2212x1659px, 45° field of view: 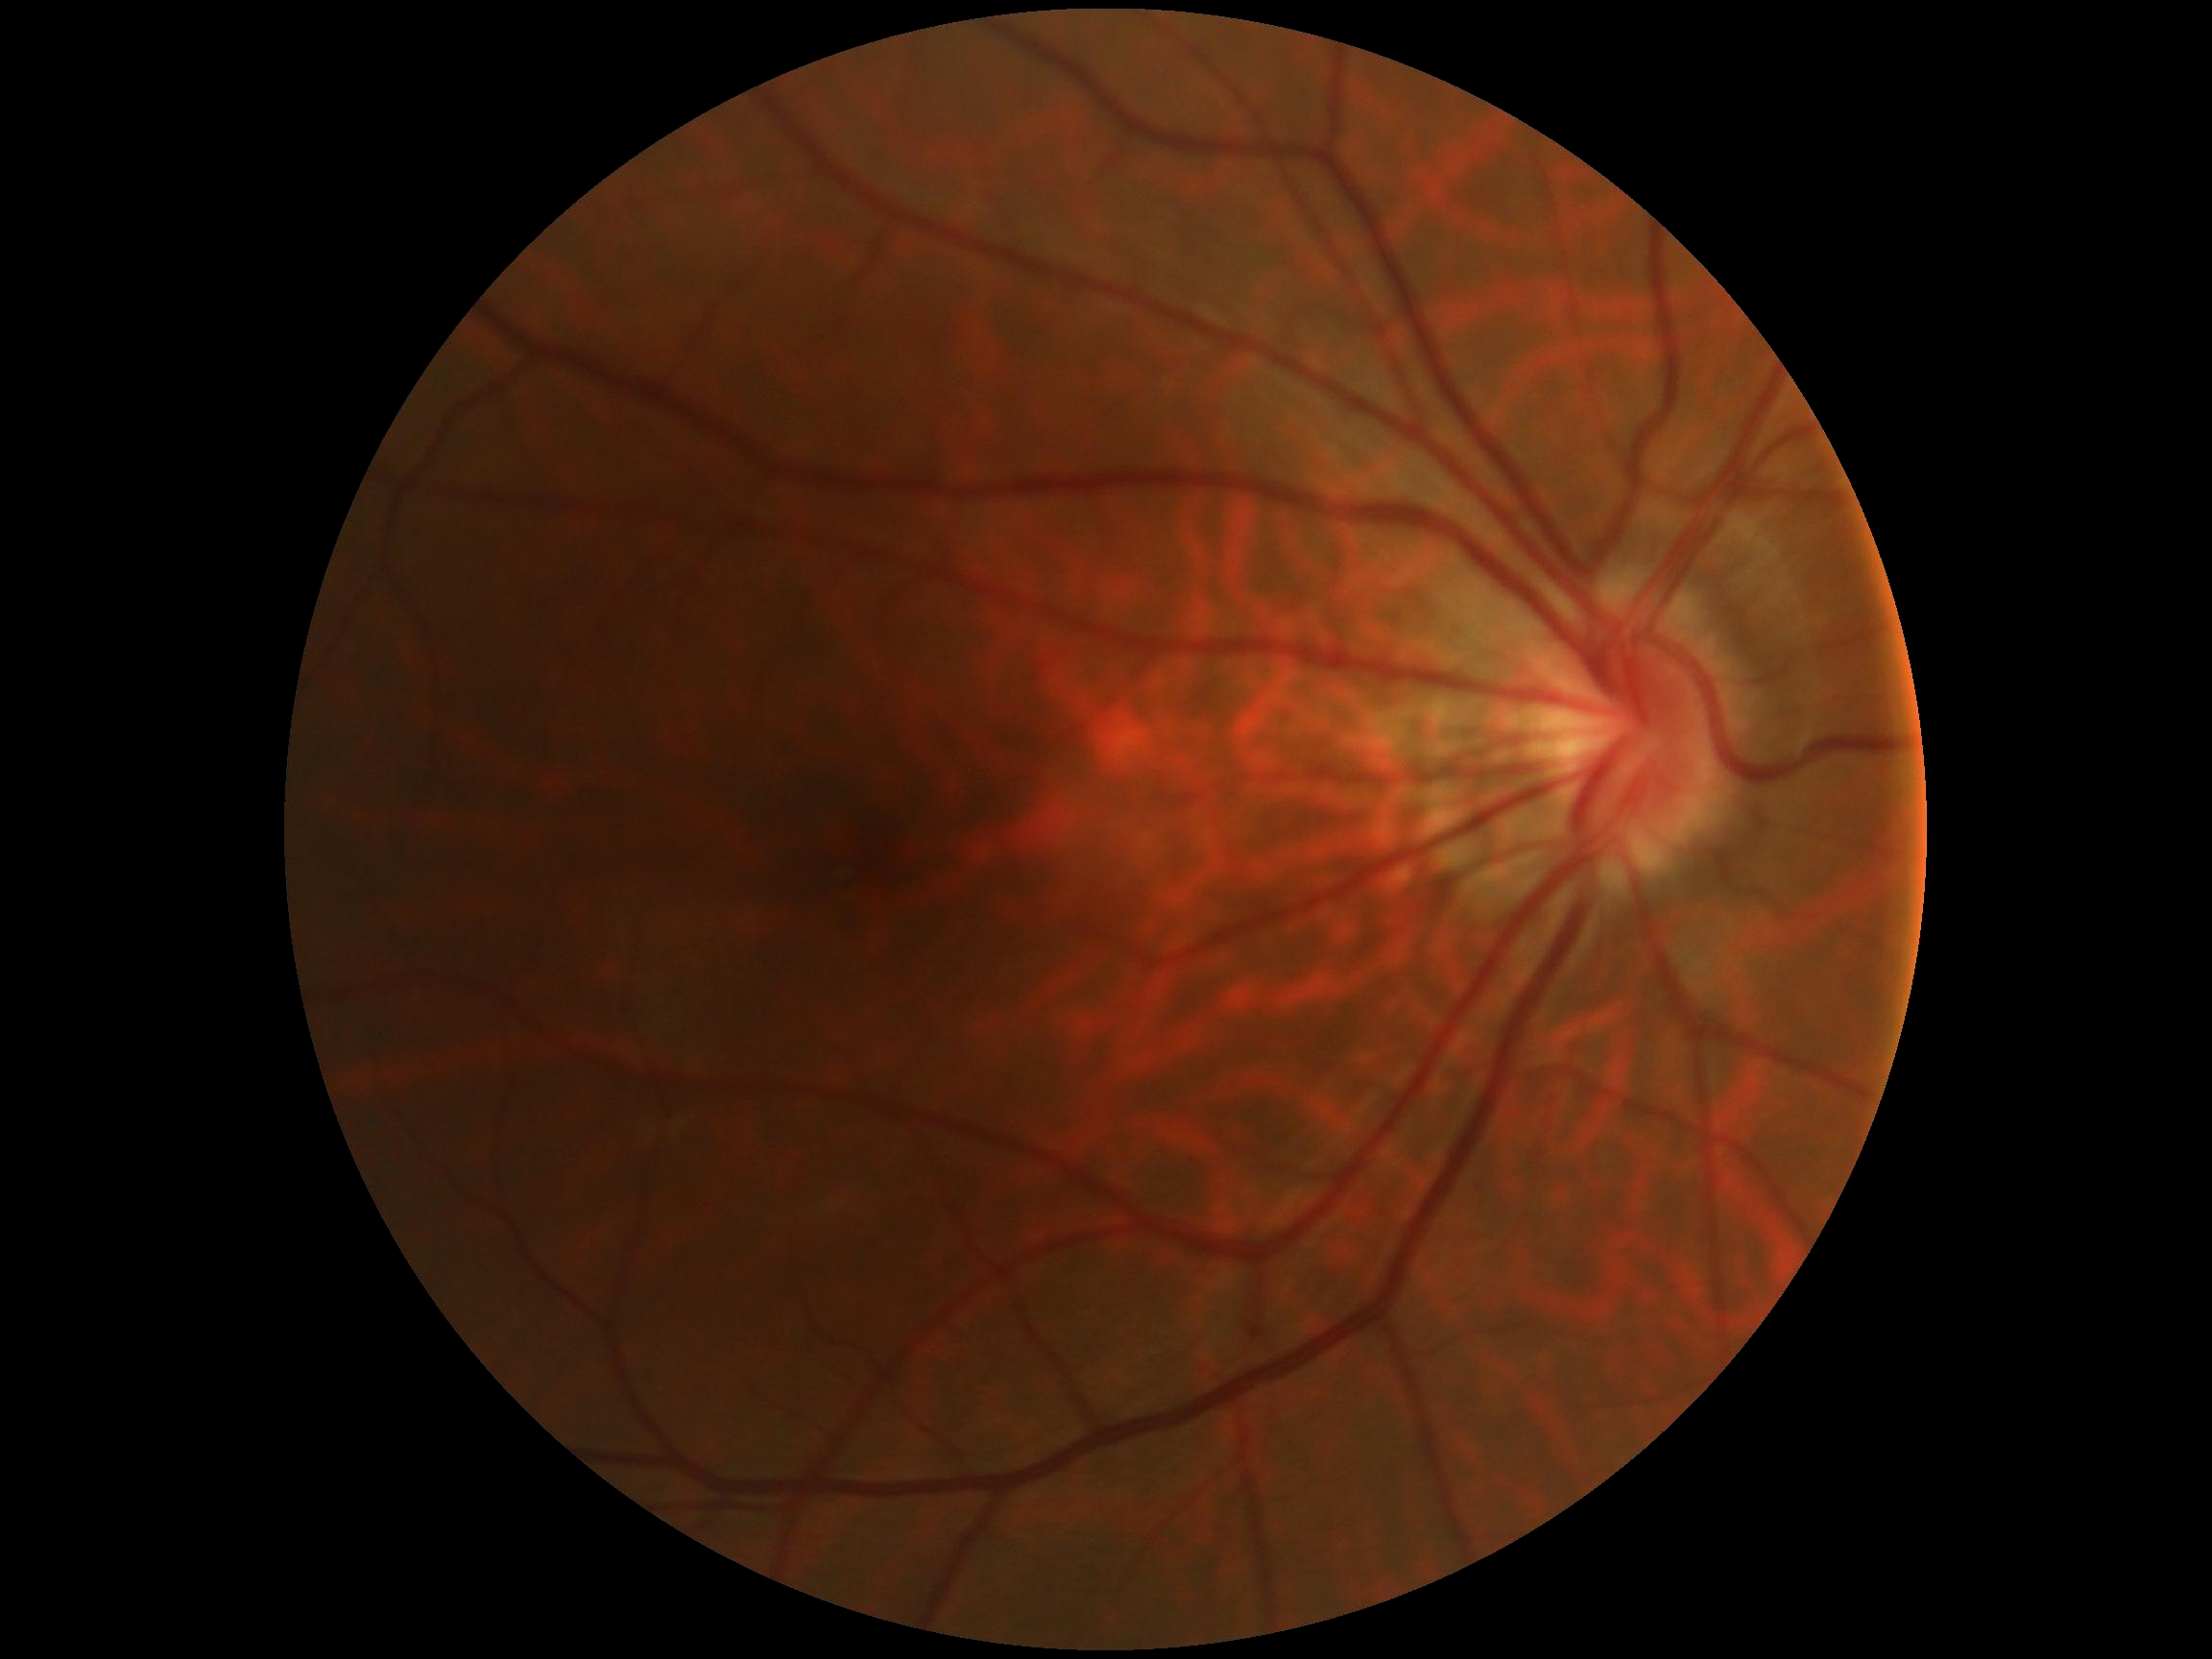

DR grade is no apparent diabetic retinopathy (0).